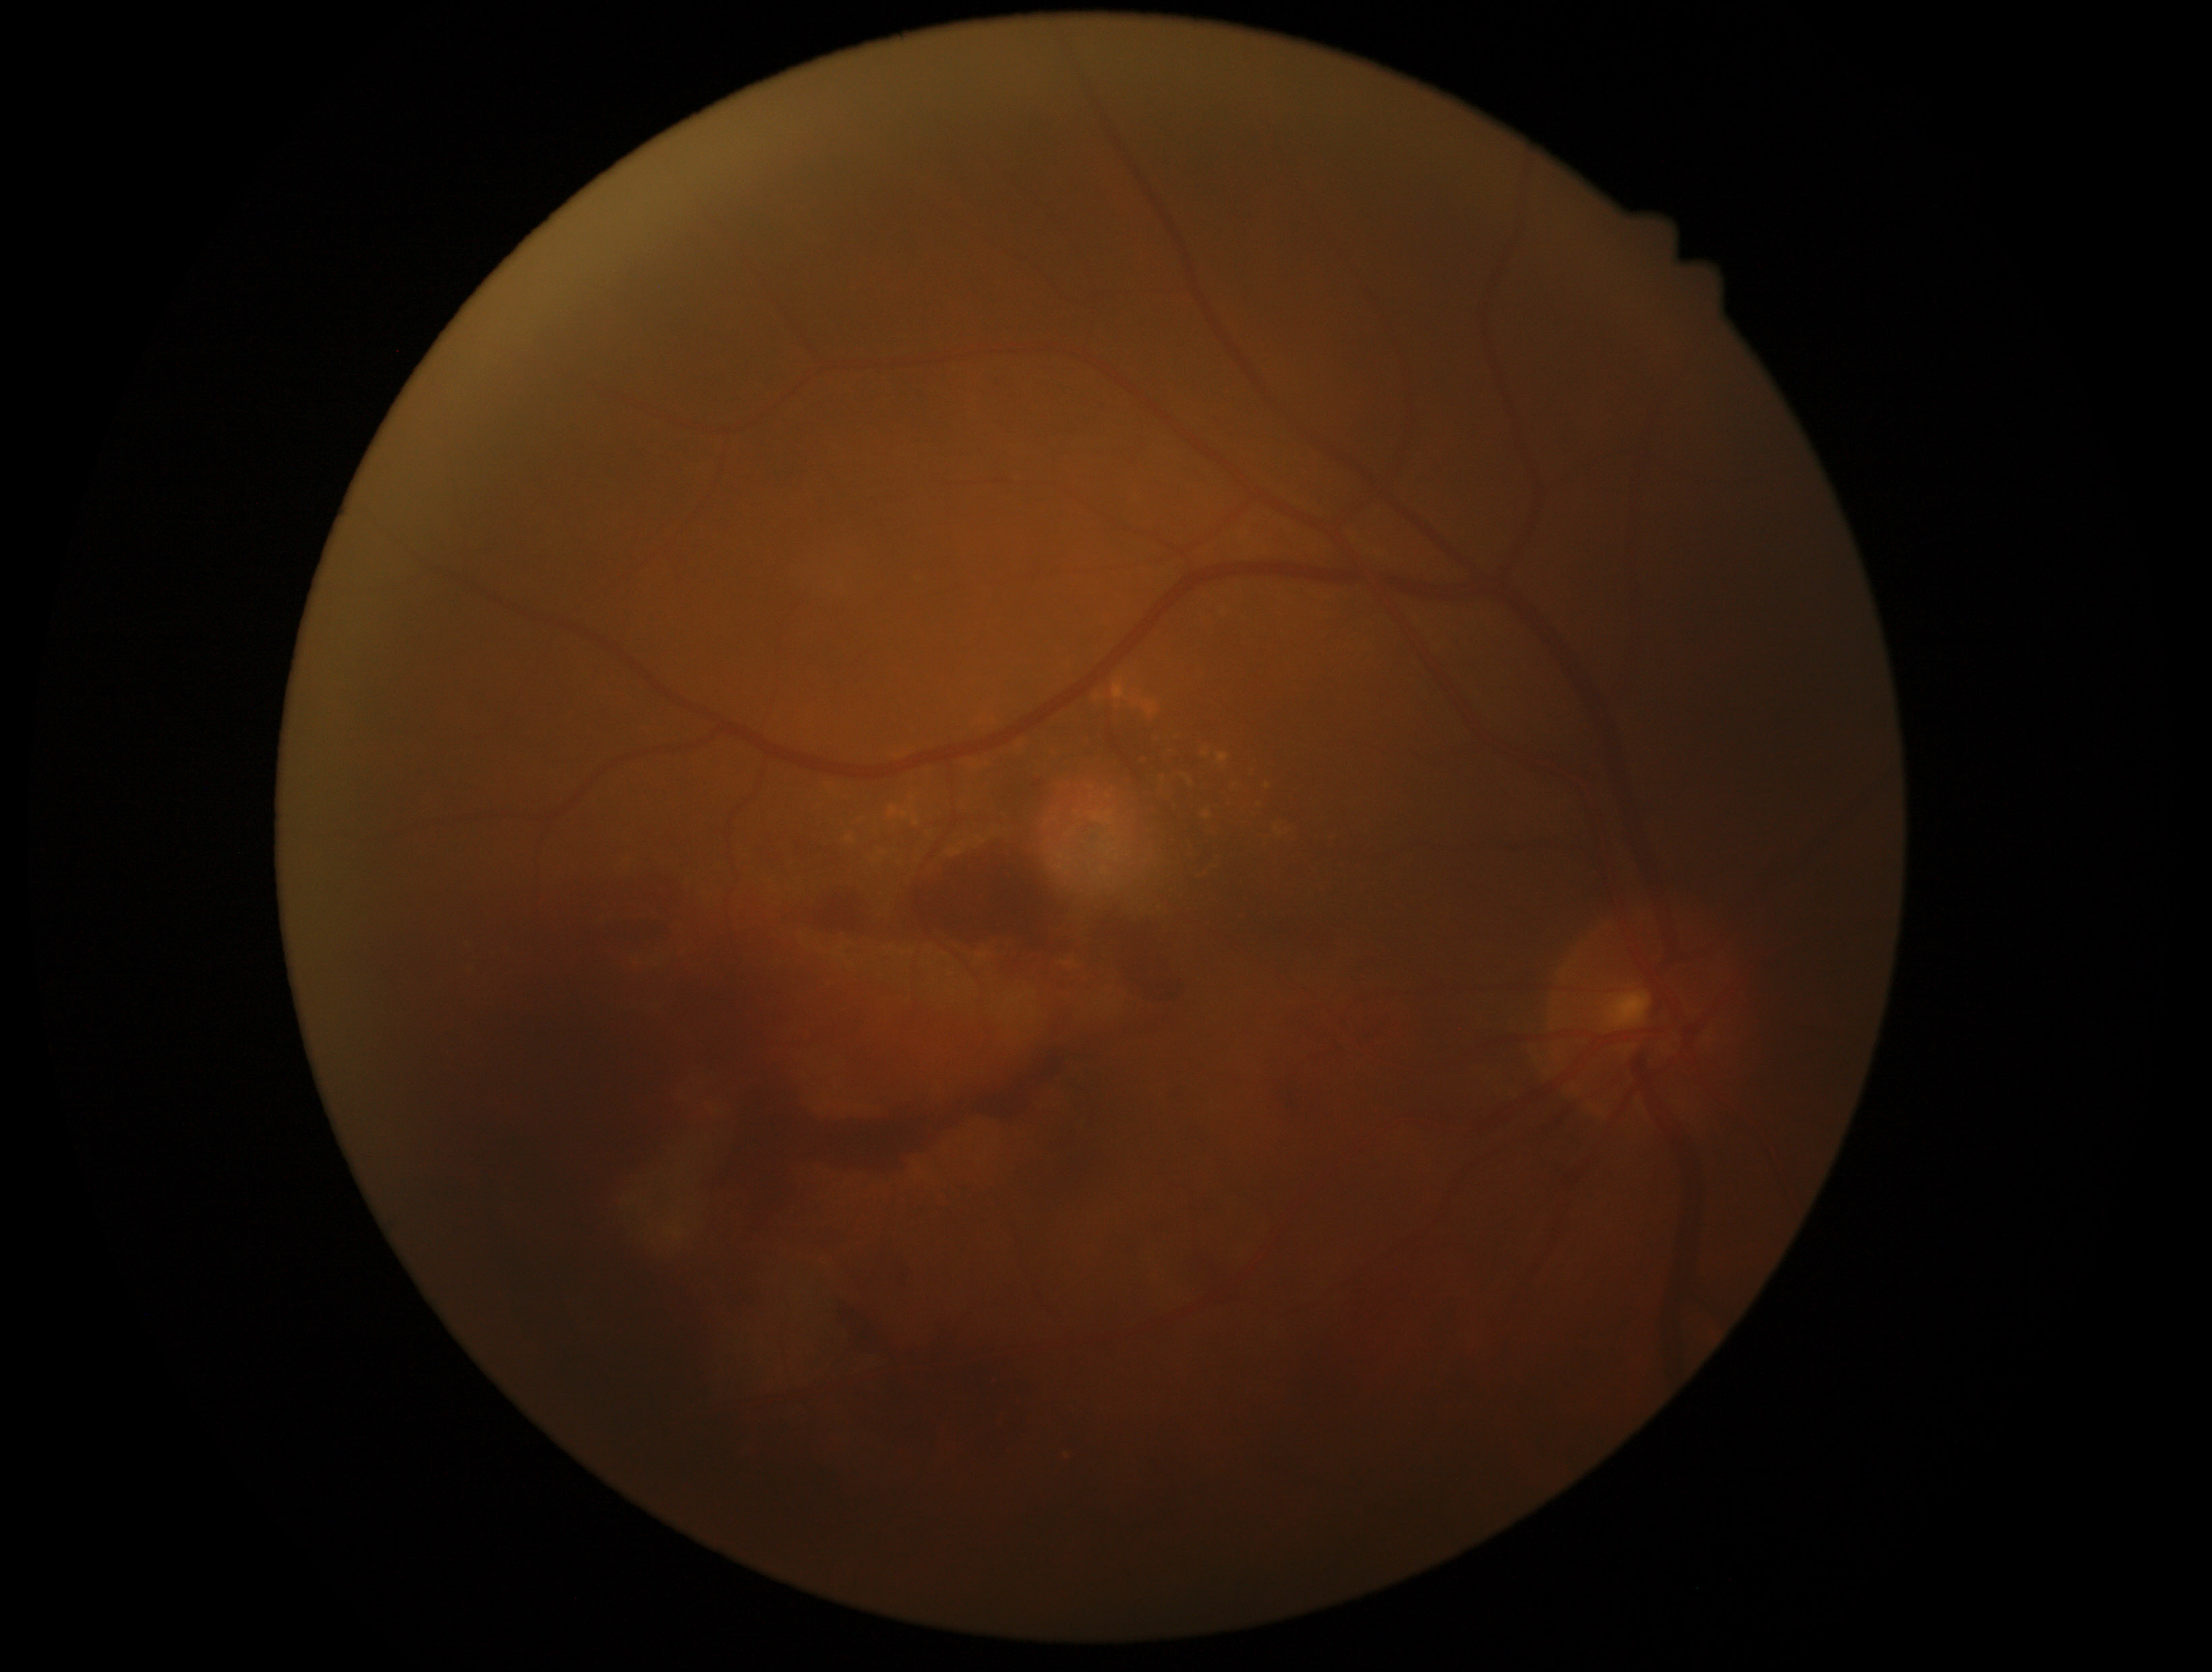 * DR — grade 4 (PDR)